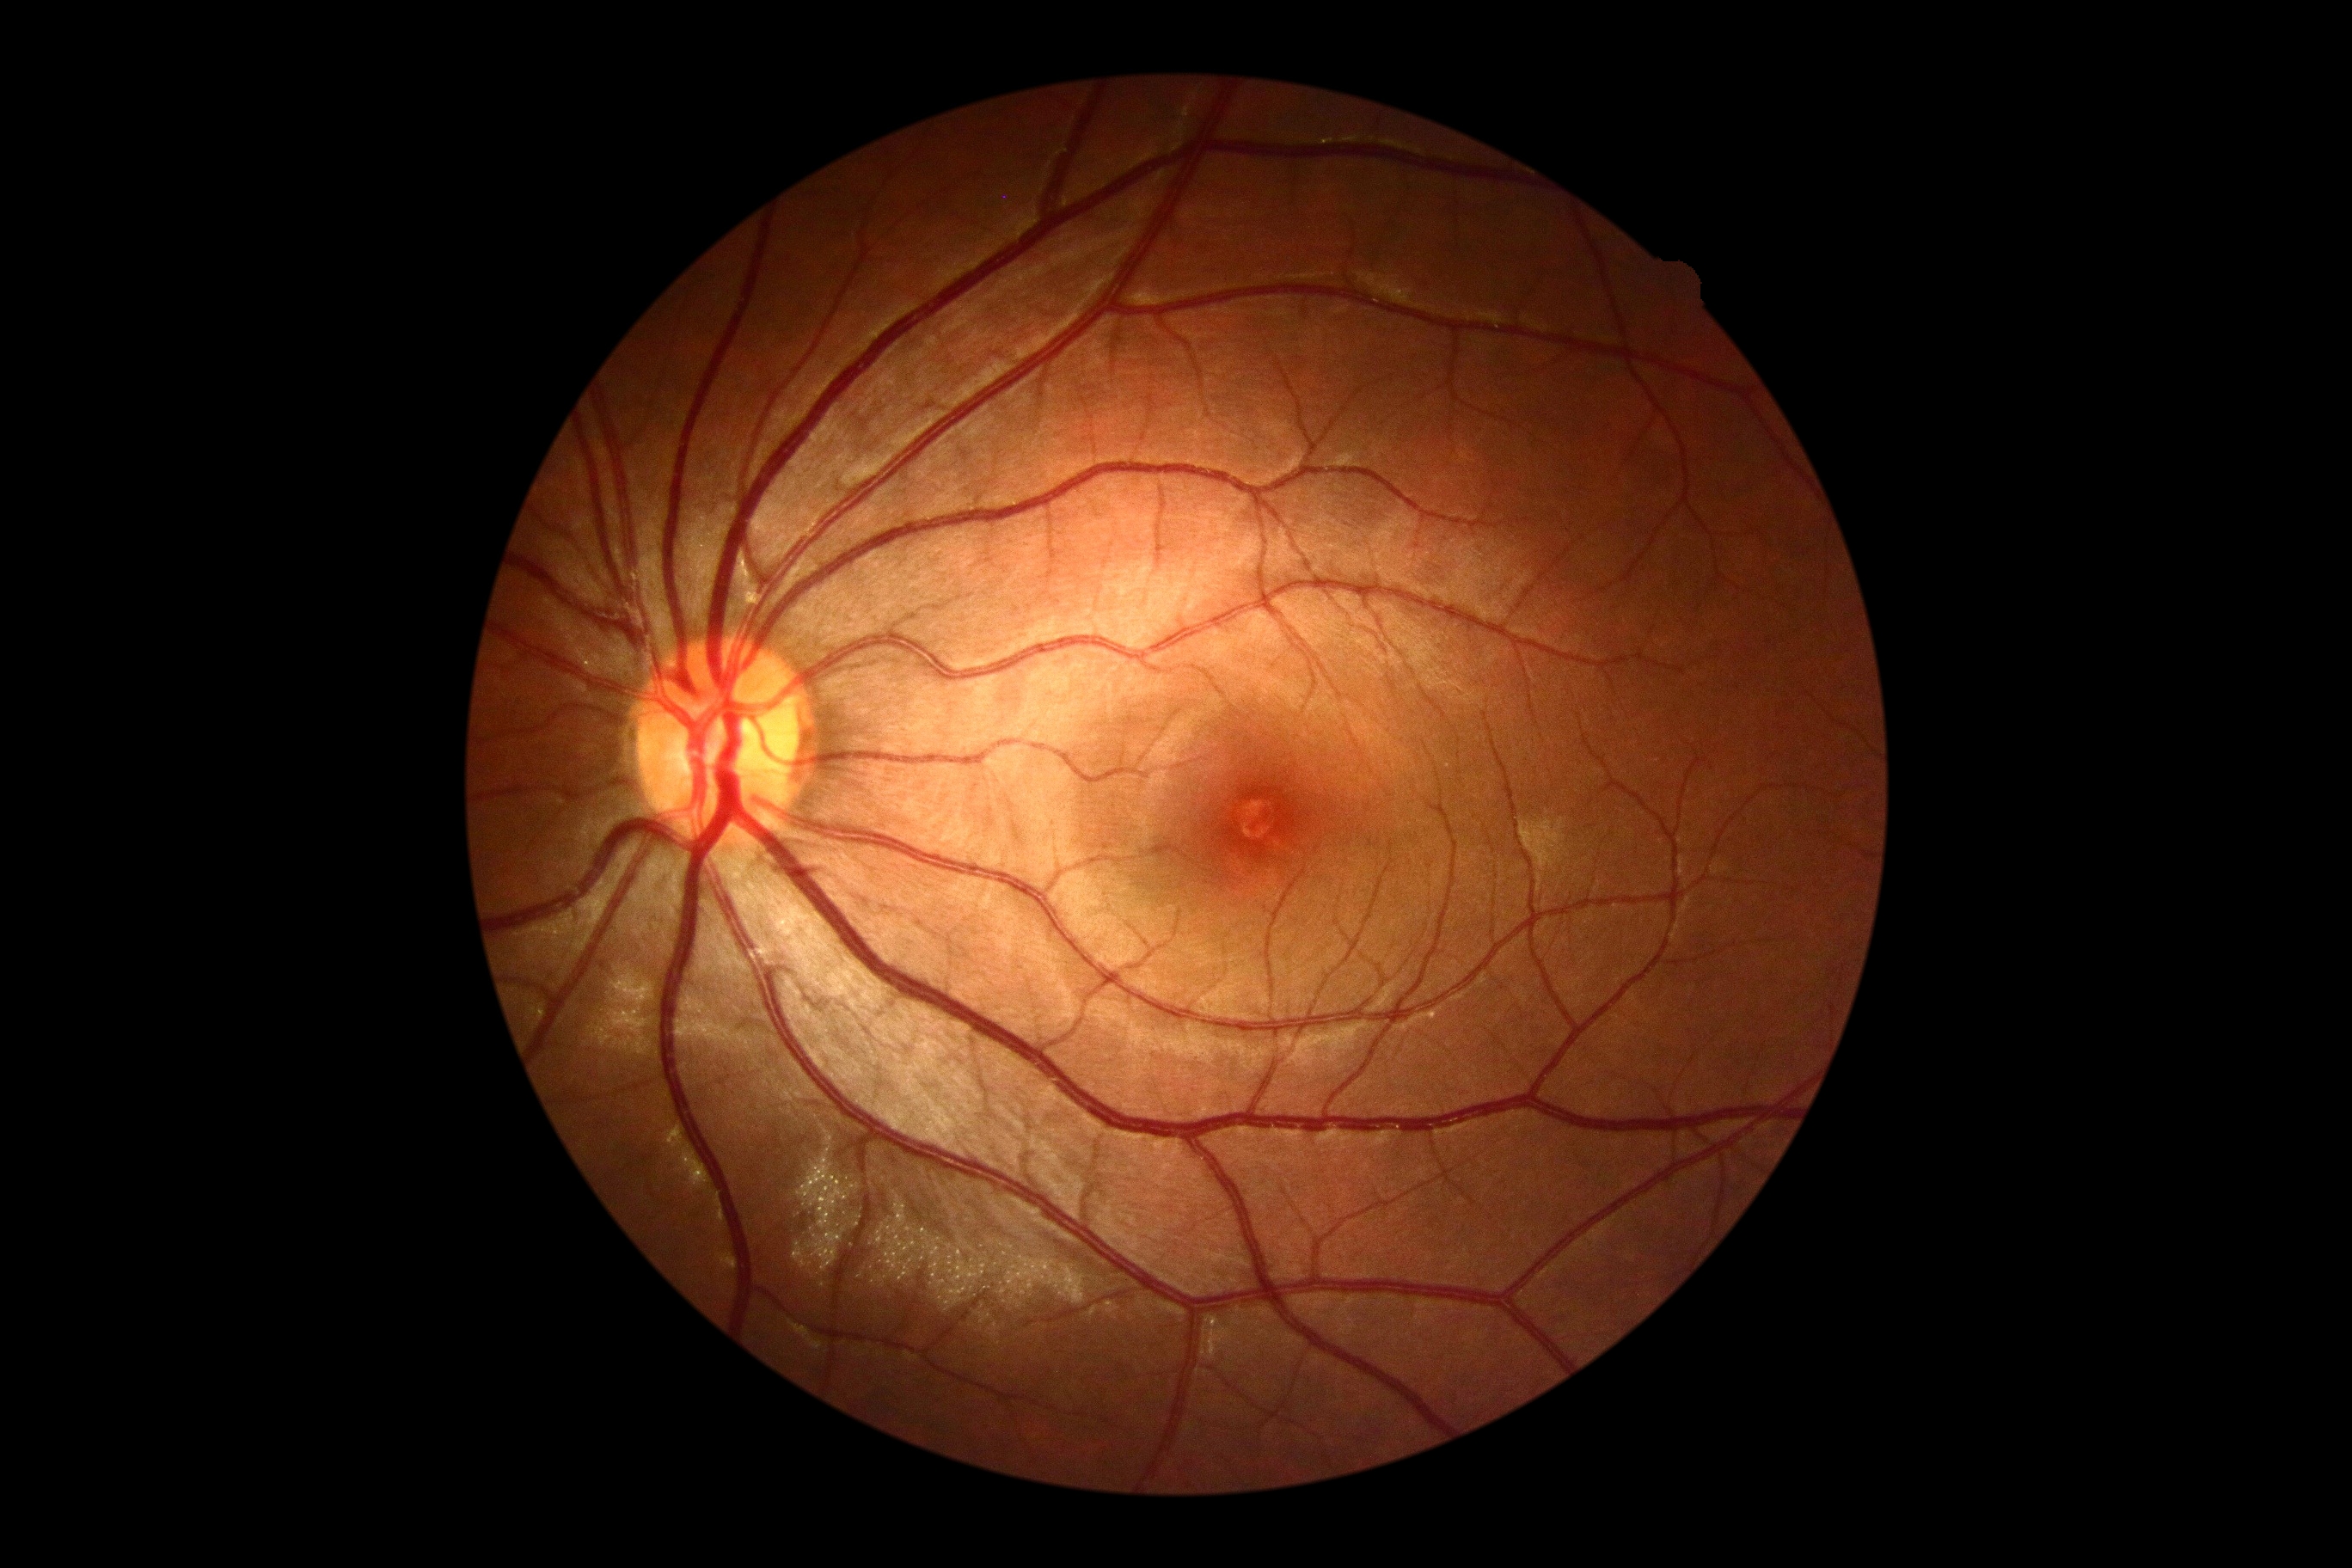
No apparent diabetic retinopathy. Diabetic retinopathy grade: 0.